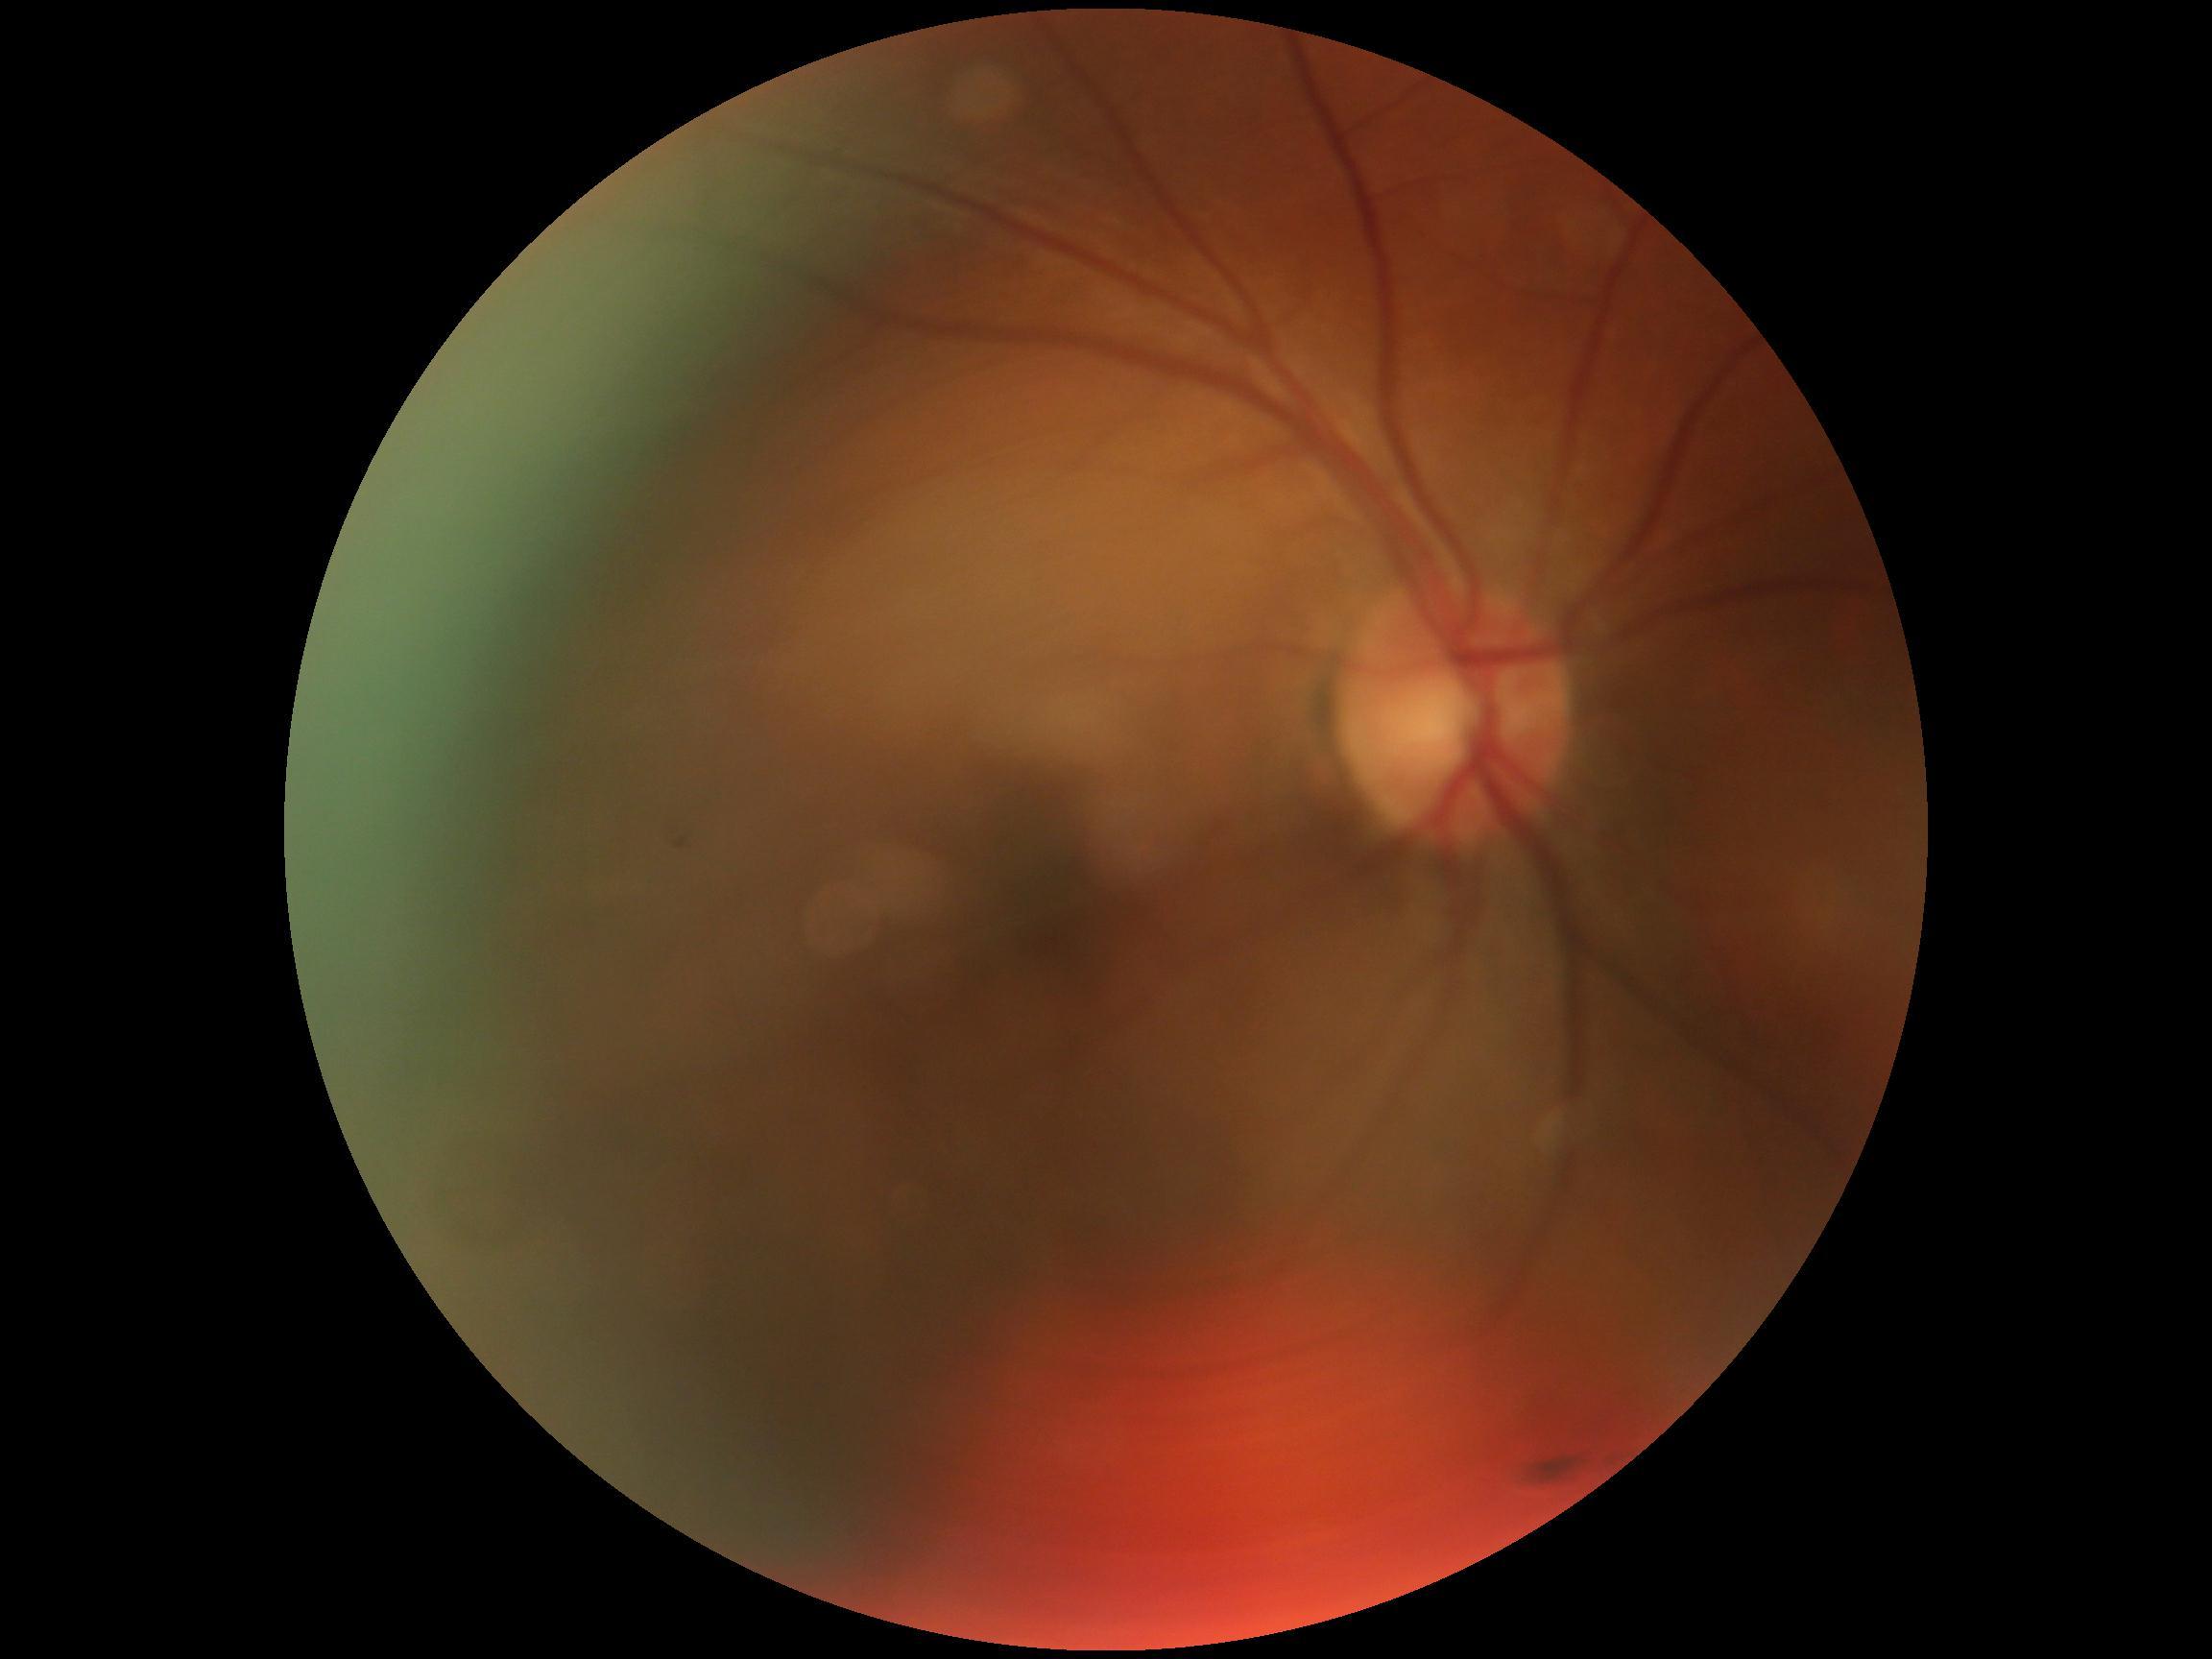
Retinopathy is grade 0 (no apparent retinopathy).